1932 x 1910 pixels:
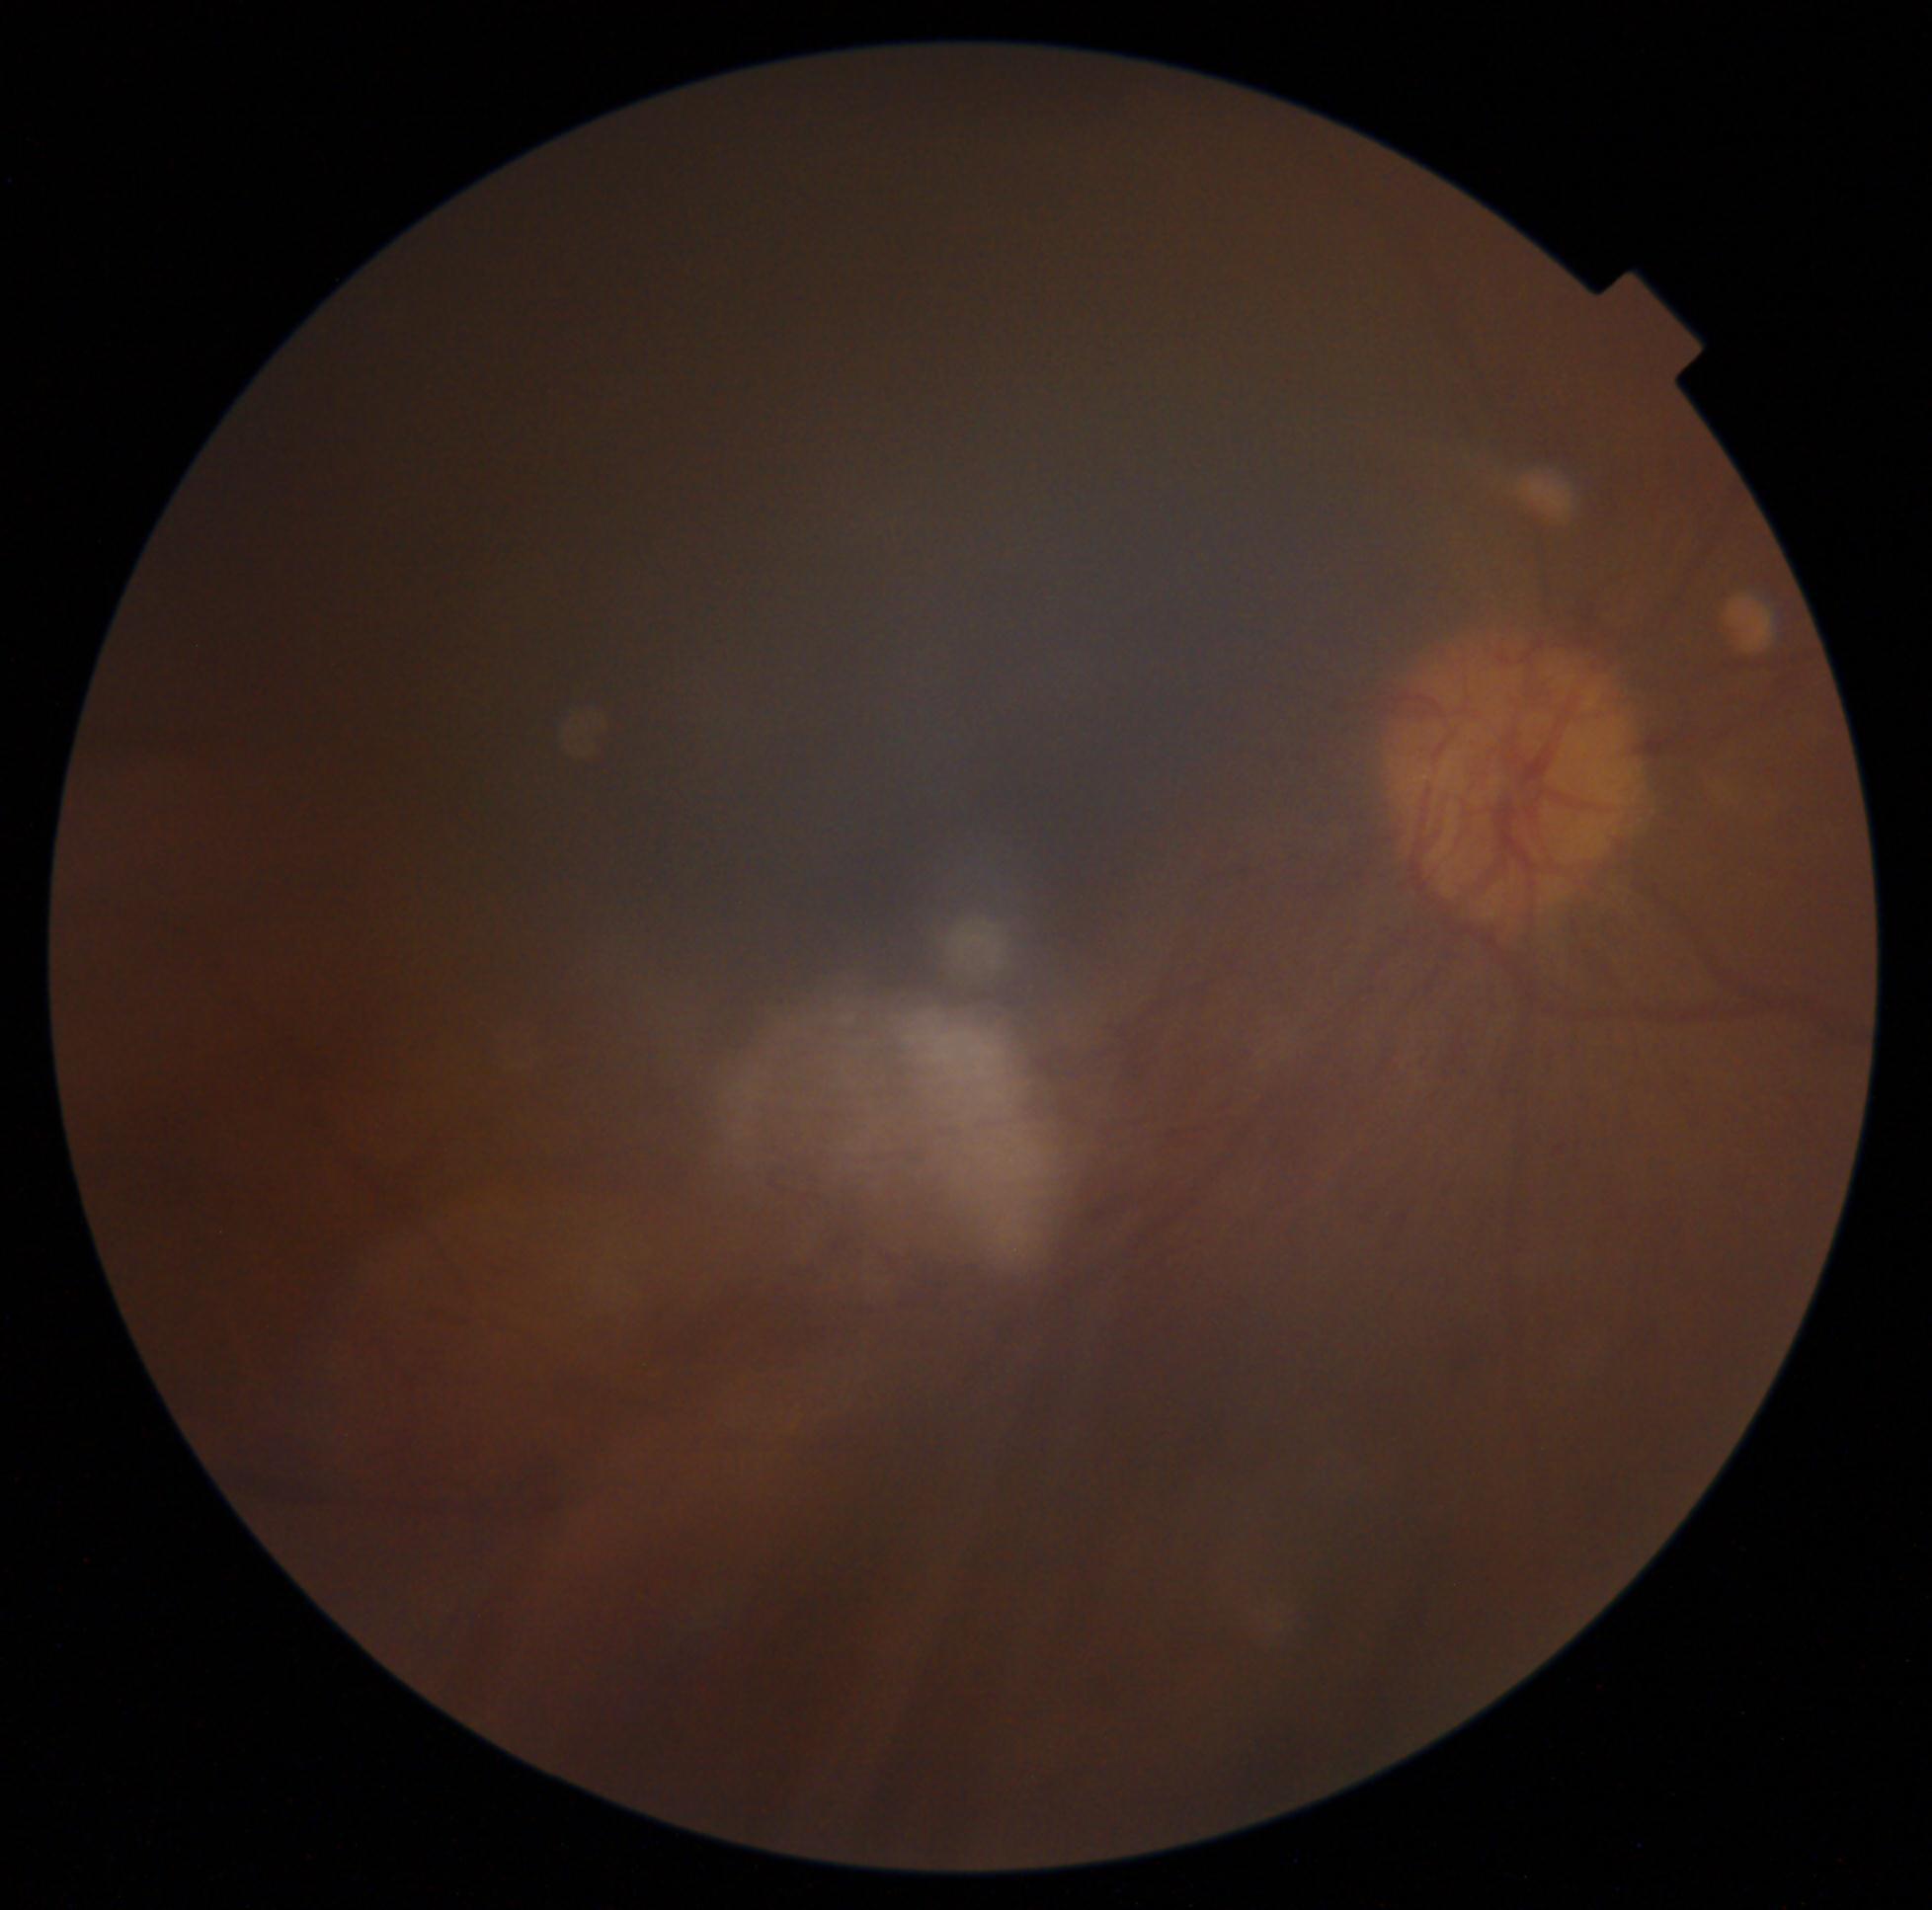
- diabetic retinopathy (DR): 4/4